Infant wide-field retinal image. 640 by 480 pixels — 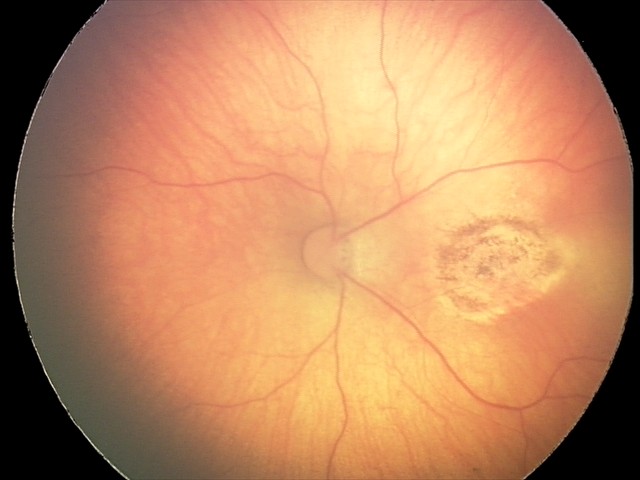
Series diagnosed as toxoplasmosis chorioretinitis.